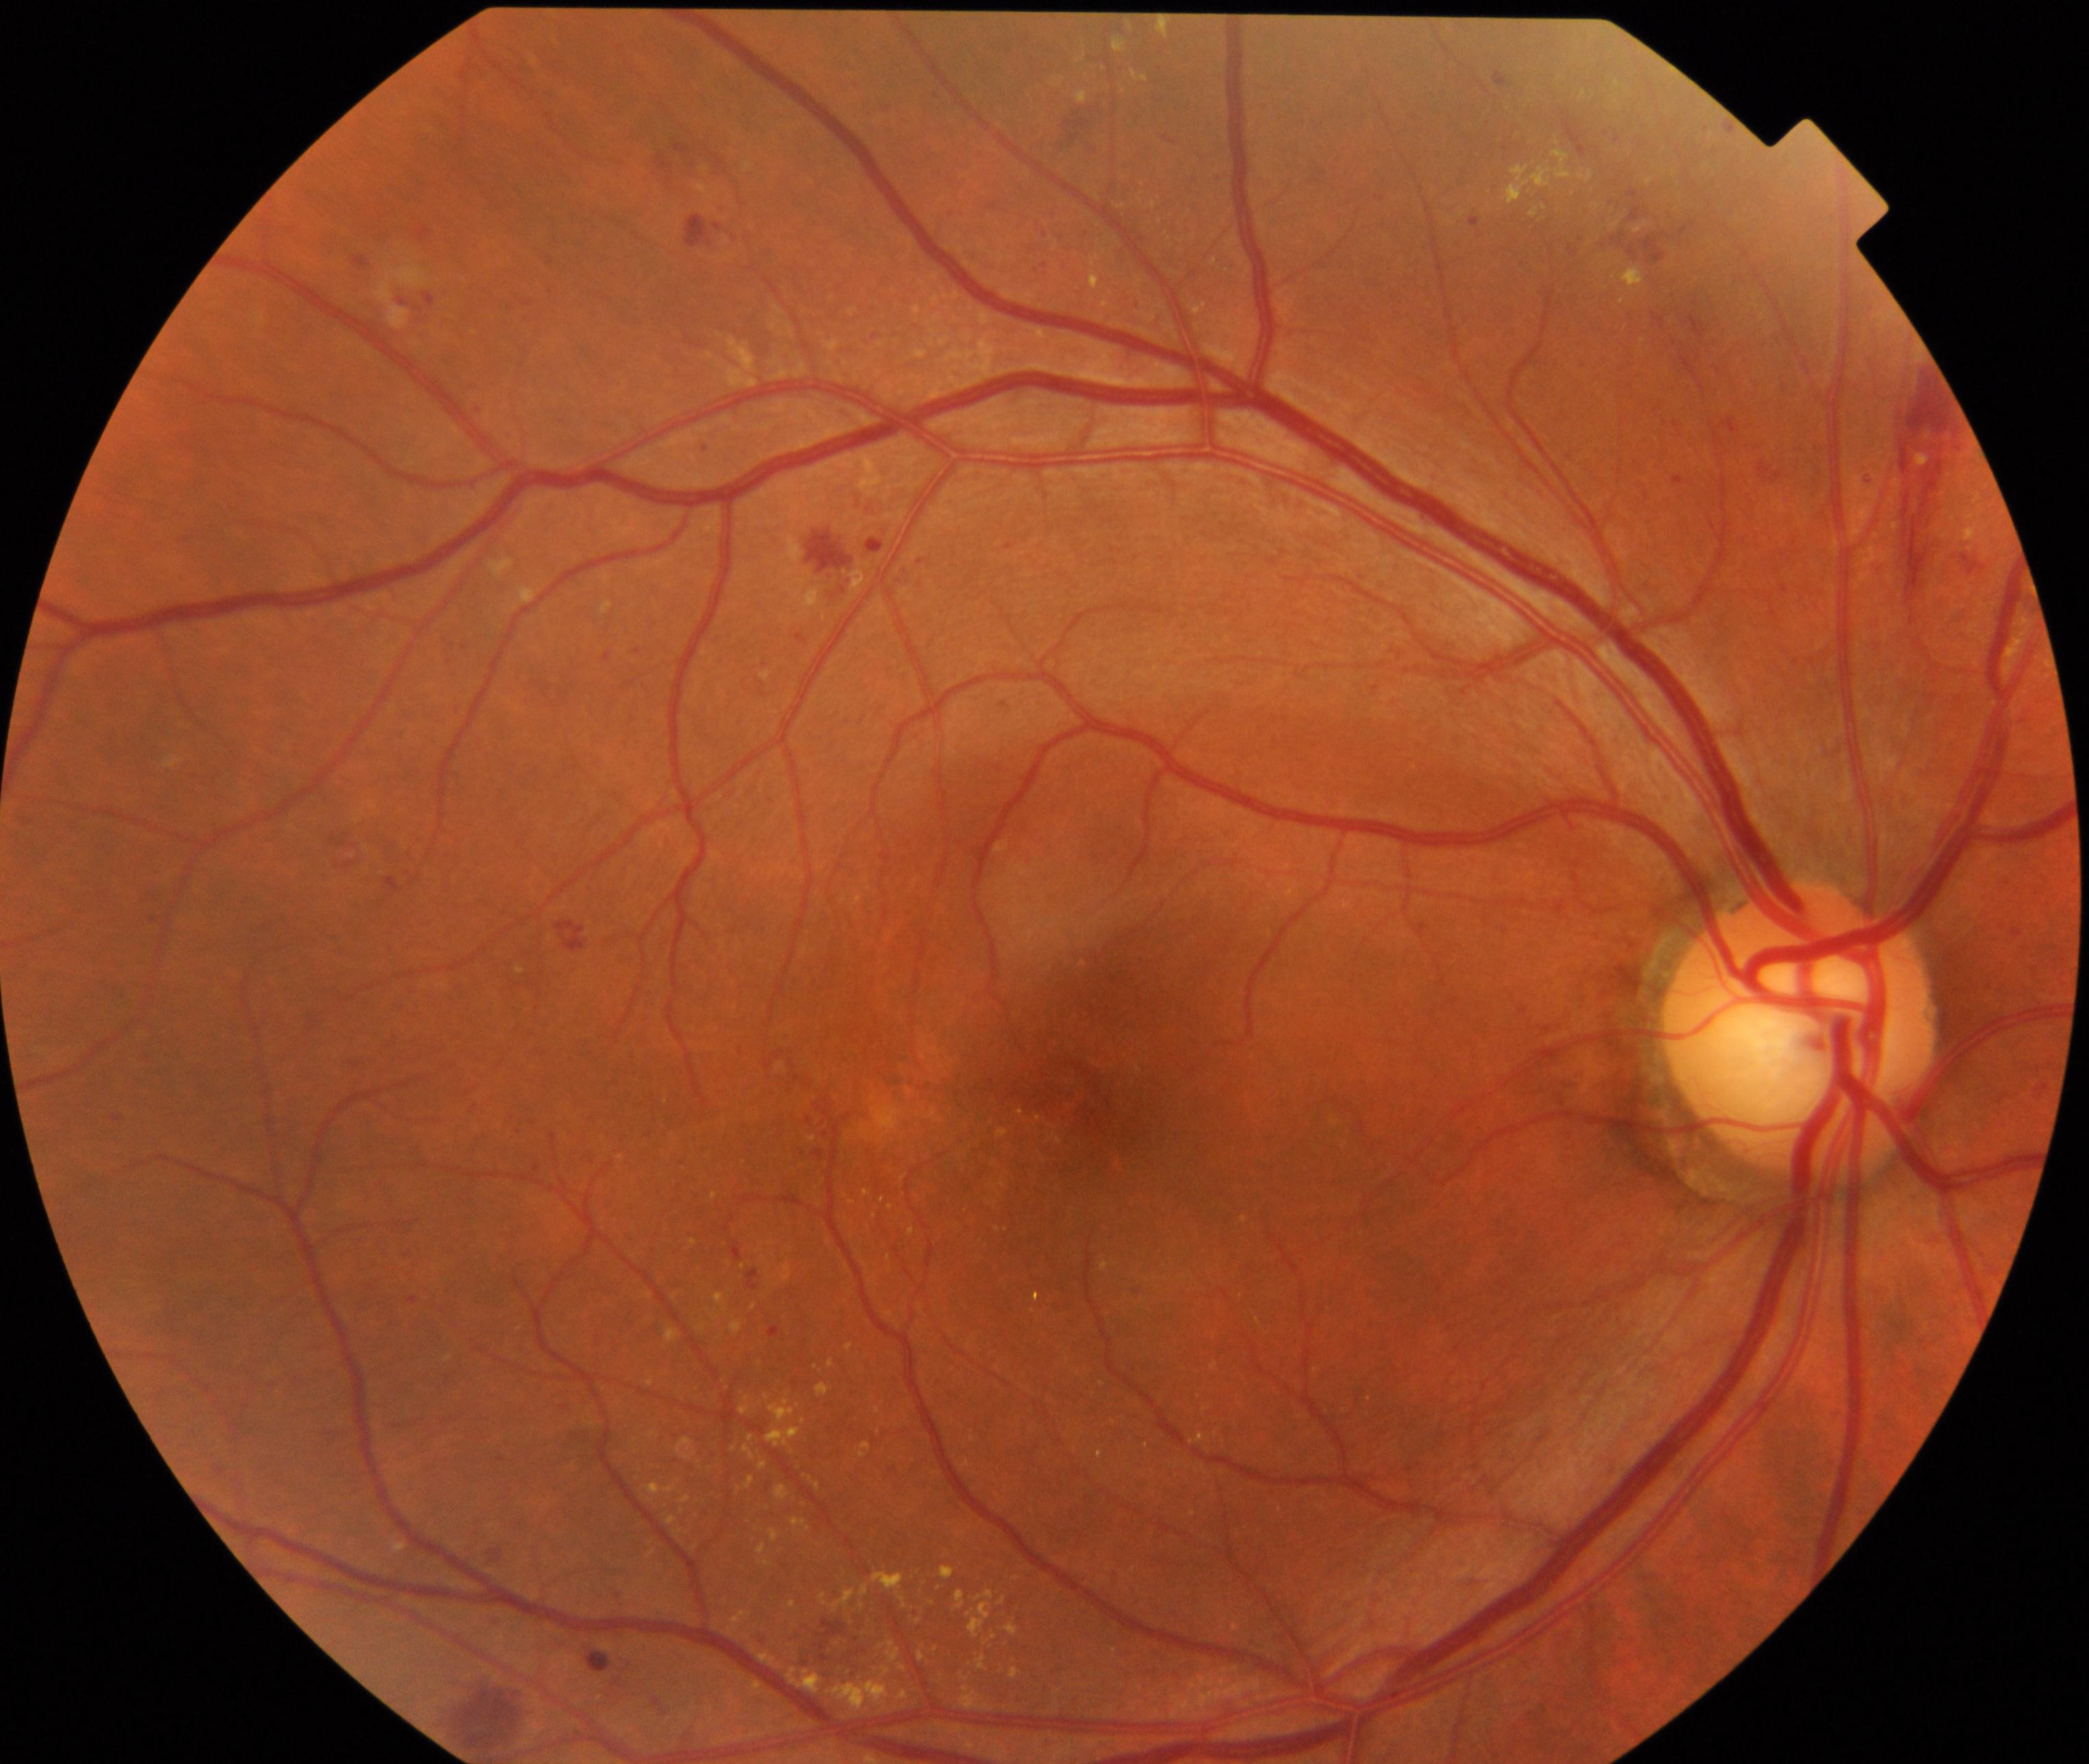 Primary finding: moderate non-proliferative diabetic retinopathy.